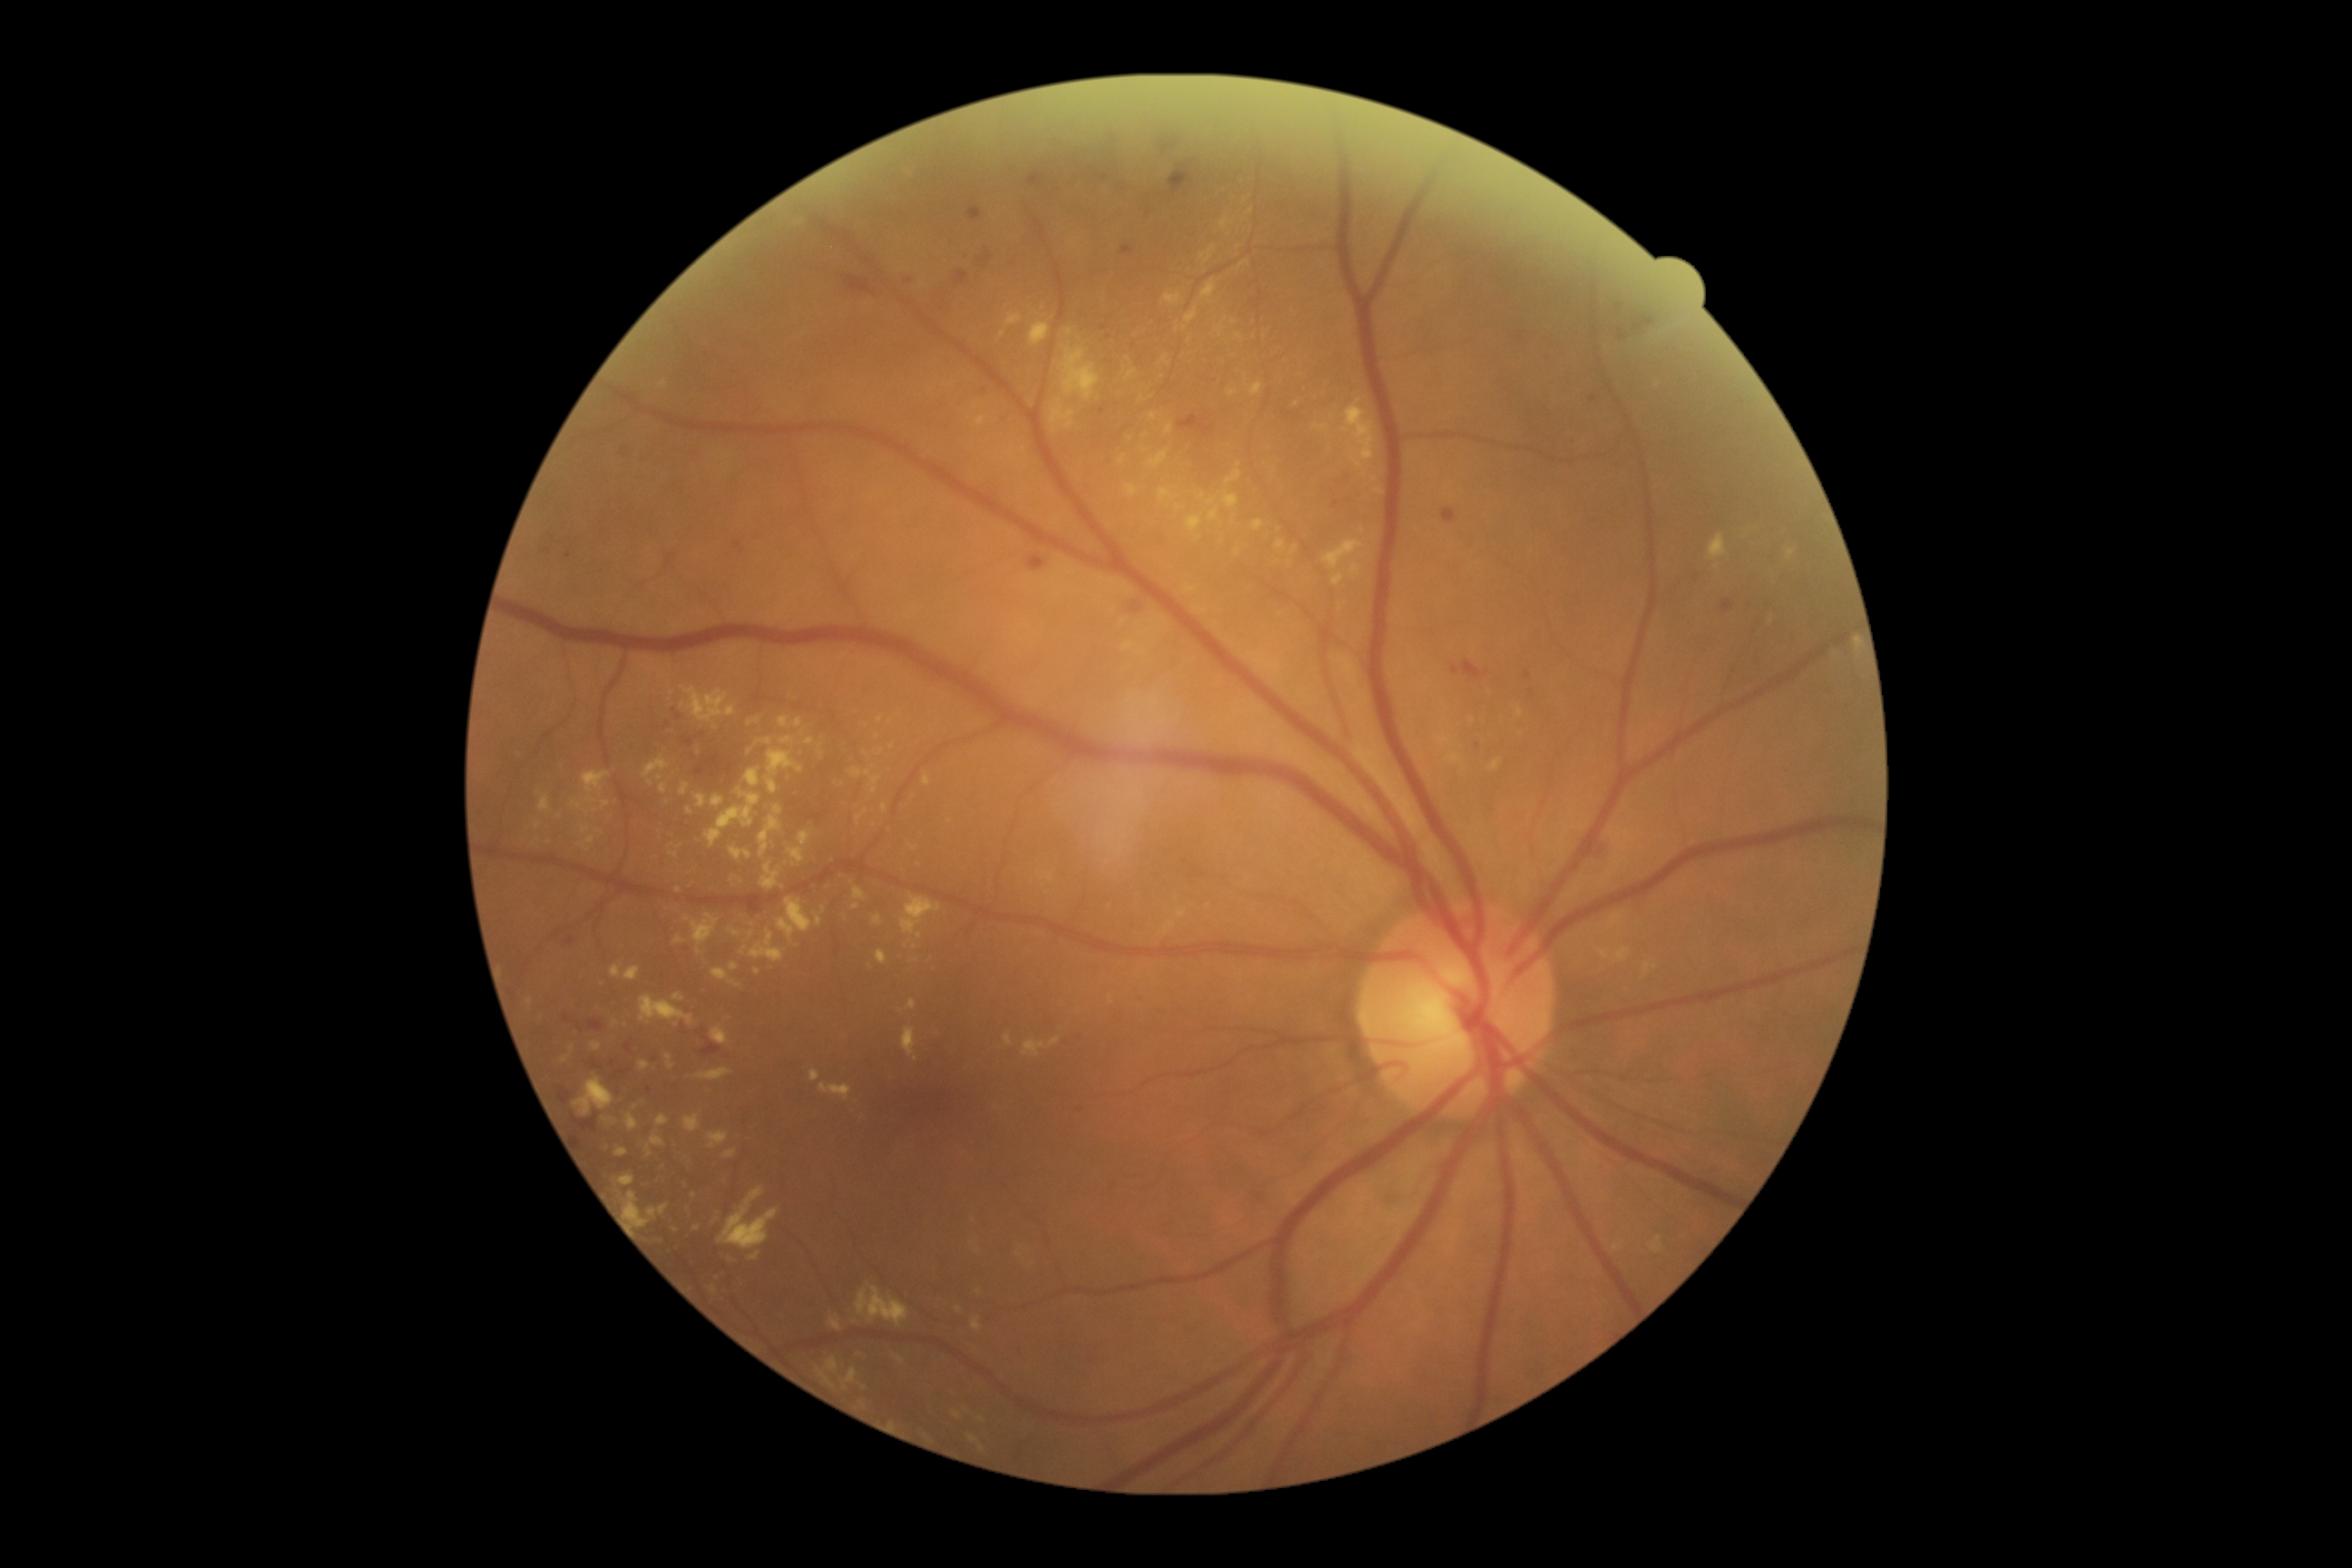

DR stage: 2. MAs include those at left=1121, top=246, right=1133, bottom=257, left=571, top=1115, right=598, bottom=1133, left=565, top=937, right=574, bottom=946, left=589, top=1061, right=605, bottom=1072, left=565, top=551, right=573, bottom=560, left=625, top=1043, right=632, bottom=1054, left=558, top=1088, right=573, bottom=1106, left=1475, top=743, right=1482, bottom=752. Small MAs near {"x": 1081, "y": 1110}, {"x": 579, "y": 1138}, {"x": 1593, "y": 399}. EXs include those at left=968, top=1435, right=985, bottom=1451, left=828, top=1317, right=843, bottom=1331, left=1210, top=507, right=1219, bottom=522, left=691, top=914, right=720, bottom=956, left=647, top=1144, right=654, bottom=1157, left=1006, top=315, right=1021, bottom=328, left=718, top=1188, right=779, bottom=1250, left=674, top=936, right=685, bottom=945, left=681, top=701, right=685, bottom=709, left=1709, top=534, right=1727, bottom=562, left=972, top=1317, right=983, bottom=1331, left=1373, top=489, right=1384, bottom=496, left=1612, top=1246, right=1623, bottom=1251. Small EXs near {"x": 982, "y": 1420}, {"x": 1417, "y": 456}, {"x": 794, "y": 865}, {"x": 880, "y": 720}, {"x": 537, "y": 826}, {"x": 1198, "y": 538}. HEs include those at left=1026, top=168, right=1061, bottom=195, left=694, top=754, right=736, bottom=778, left=1616, top=322, right=1631, bottom=342, left=1159, top=135, right=1182, bottom=155, left=701, top=1041, right=721, bottom=1057, left=1159, top=159, right=1200, bottom=199, left=1442, top=507, right=1458, bottom=525, left=1068, top=155, right=1113, bottom=184, left=576, top=1023, right=583, bottom=1032, left=1591, top=850, right=1602, bottom=859, left=956, top=271, right=968, bottom=286, left=1720, top=600, right=1734, bottom=614. Small HEs near {"x": 679, "y": 717}, {"x": 668, "y": 726}, {"x": 701, "y": 737}. No SEs identified.